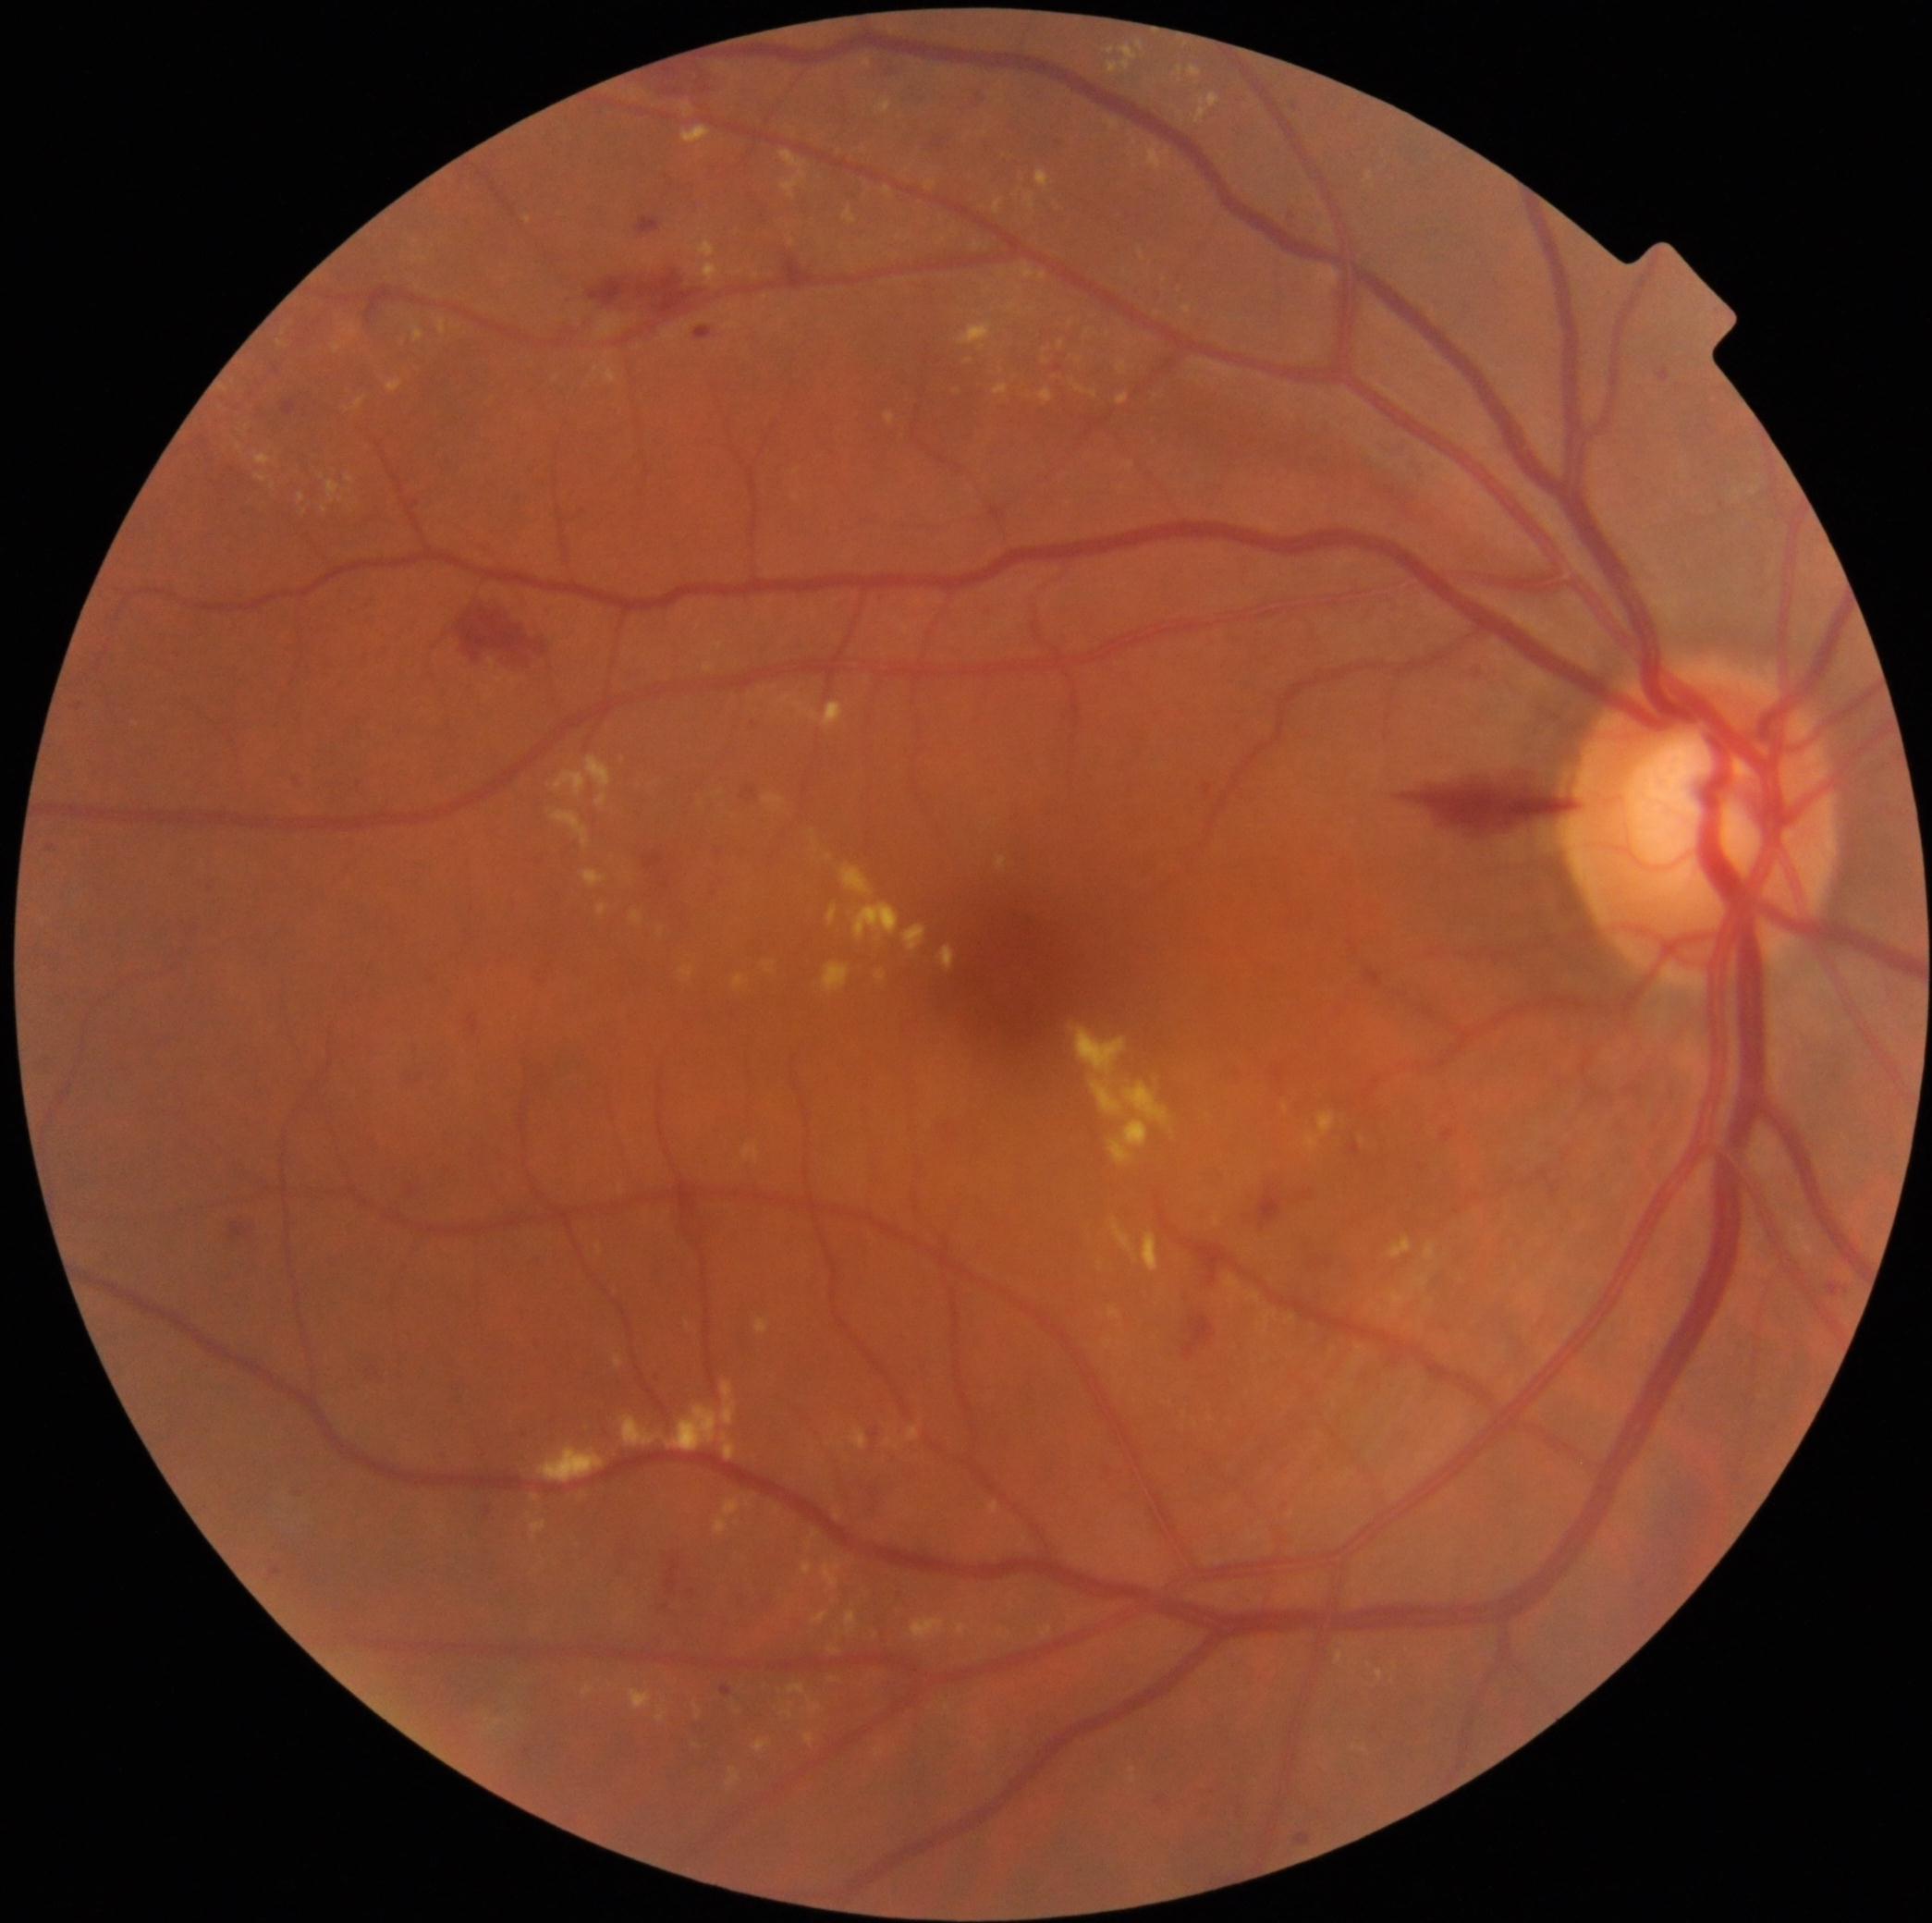 {"partial":true,"dr_grade":2,"dr_grade_name":"moderate NPDR","lesions":{"ex":[[828,1646,840,1654],[911,1618,947,1640],[764,794,786,812],[926,182,937,190],[525,216,531,224],[793,469,801,476],[1111,1218,1140,1264],[908,1426,921,1442],[877,98,892,115],[802,1562,813,1575],[826,1442,835,1446],[686,1320,691,1328],[583,1685,594,1696],[999,1627,1012,1640],[850,1427,870,1450]],"ex_small":[[1107,335],[1121,1344],[1031,310]]}}